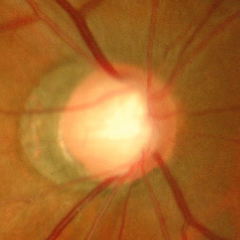 Q: Is glaucoma present?
A: Advanced glaucomatous optic neuropathy.